240 x 240 pixels:
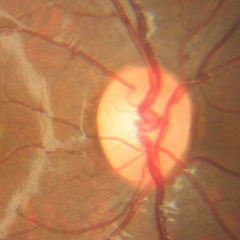

Fundus appearance consistent with no glaucomatous findings.